Graded on the modified Davis scale — 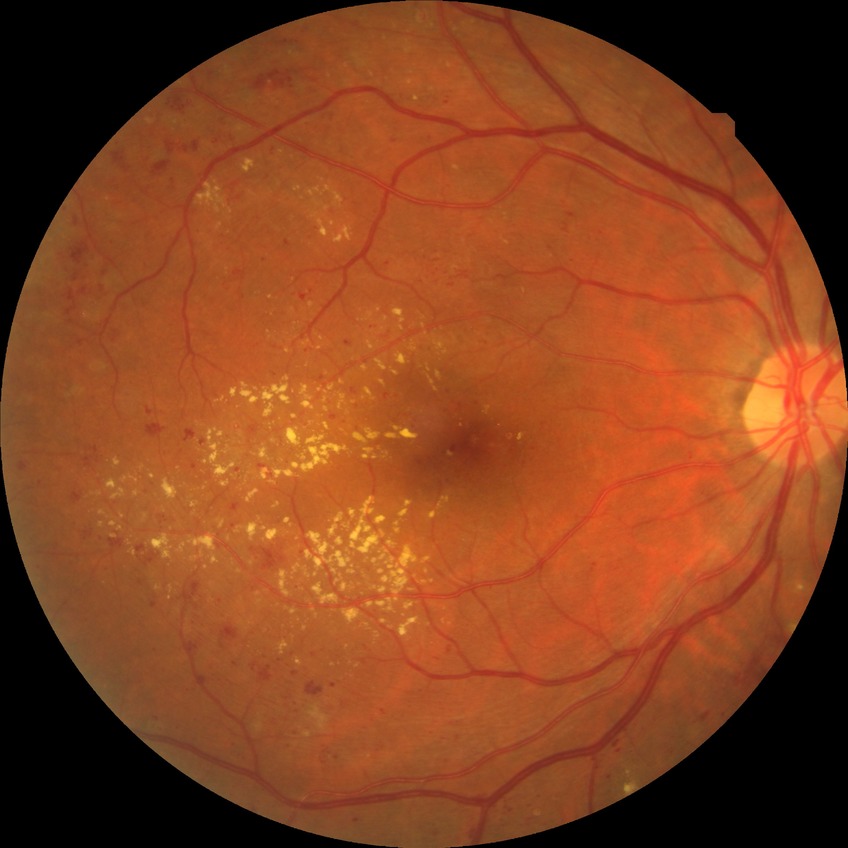
diabetic retinopathy grade@proliferative diabetic retinopathy.